Acquired with a Remidio smartphone fundus camera
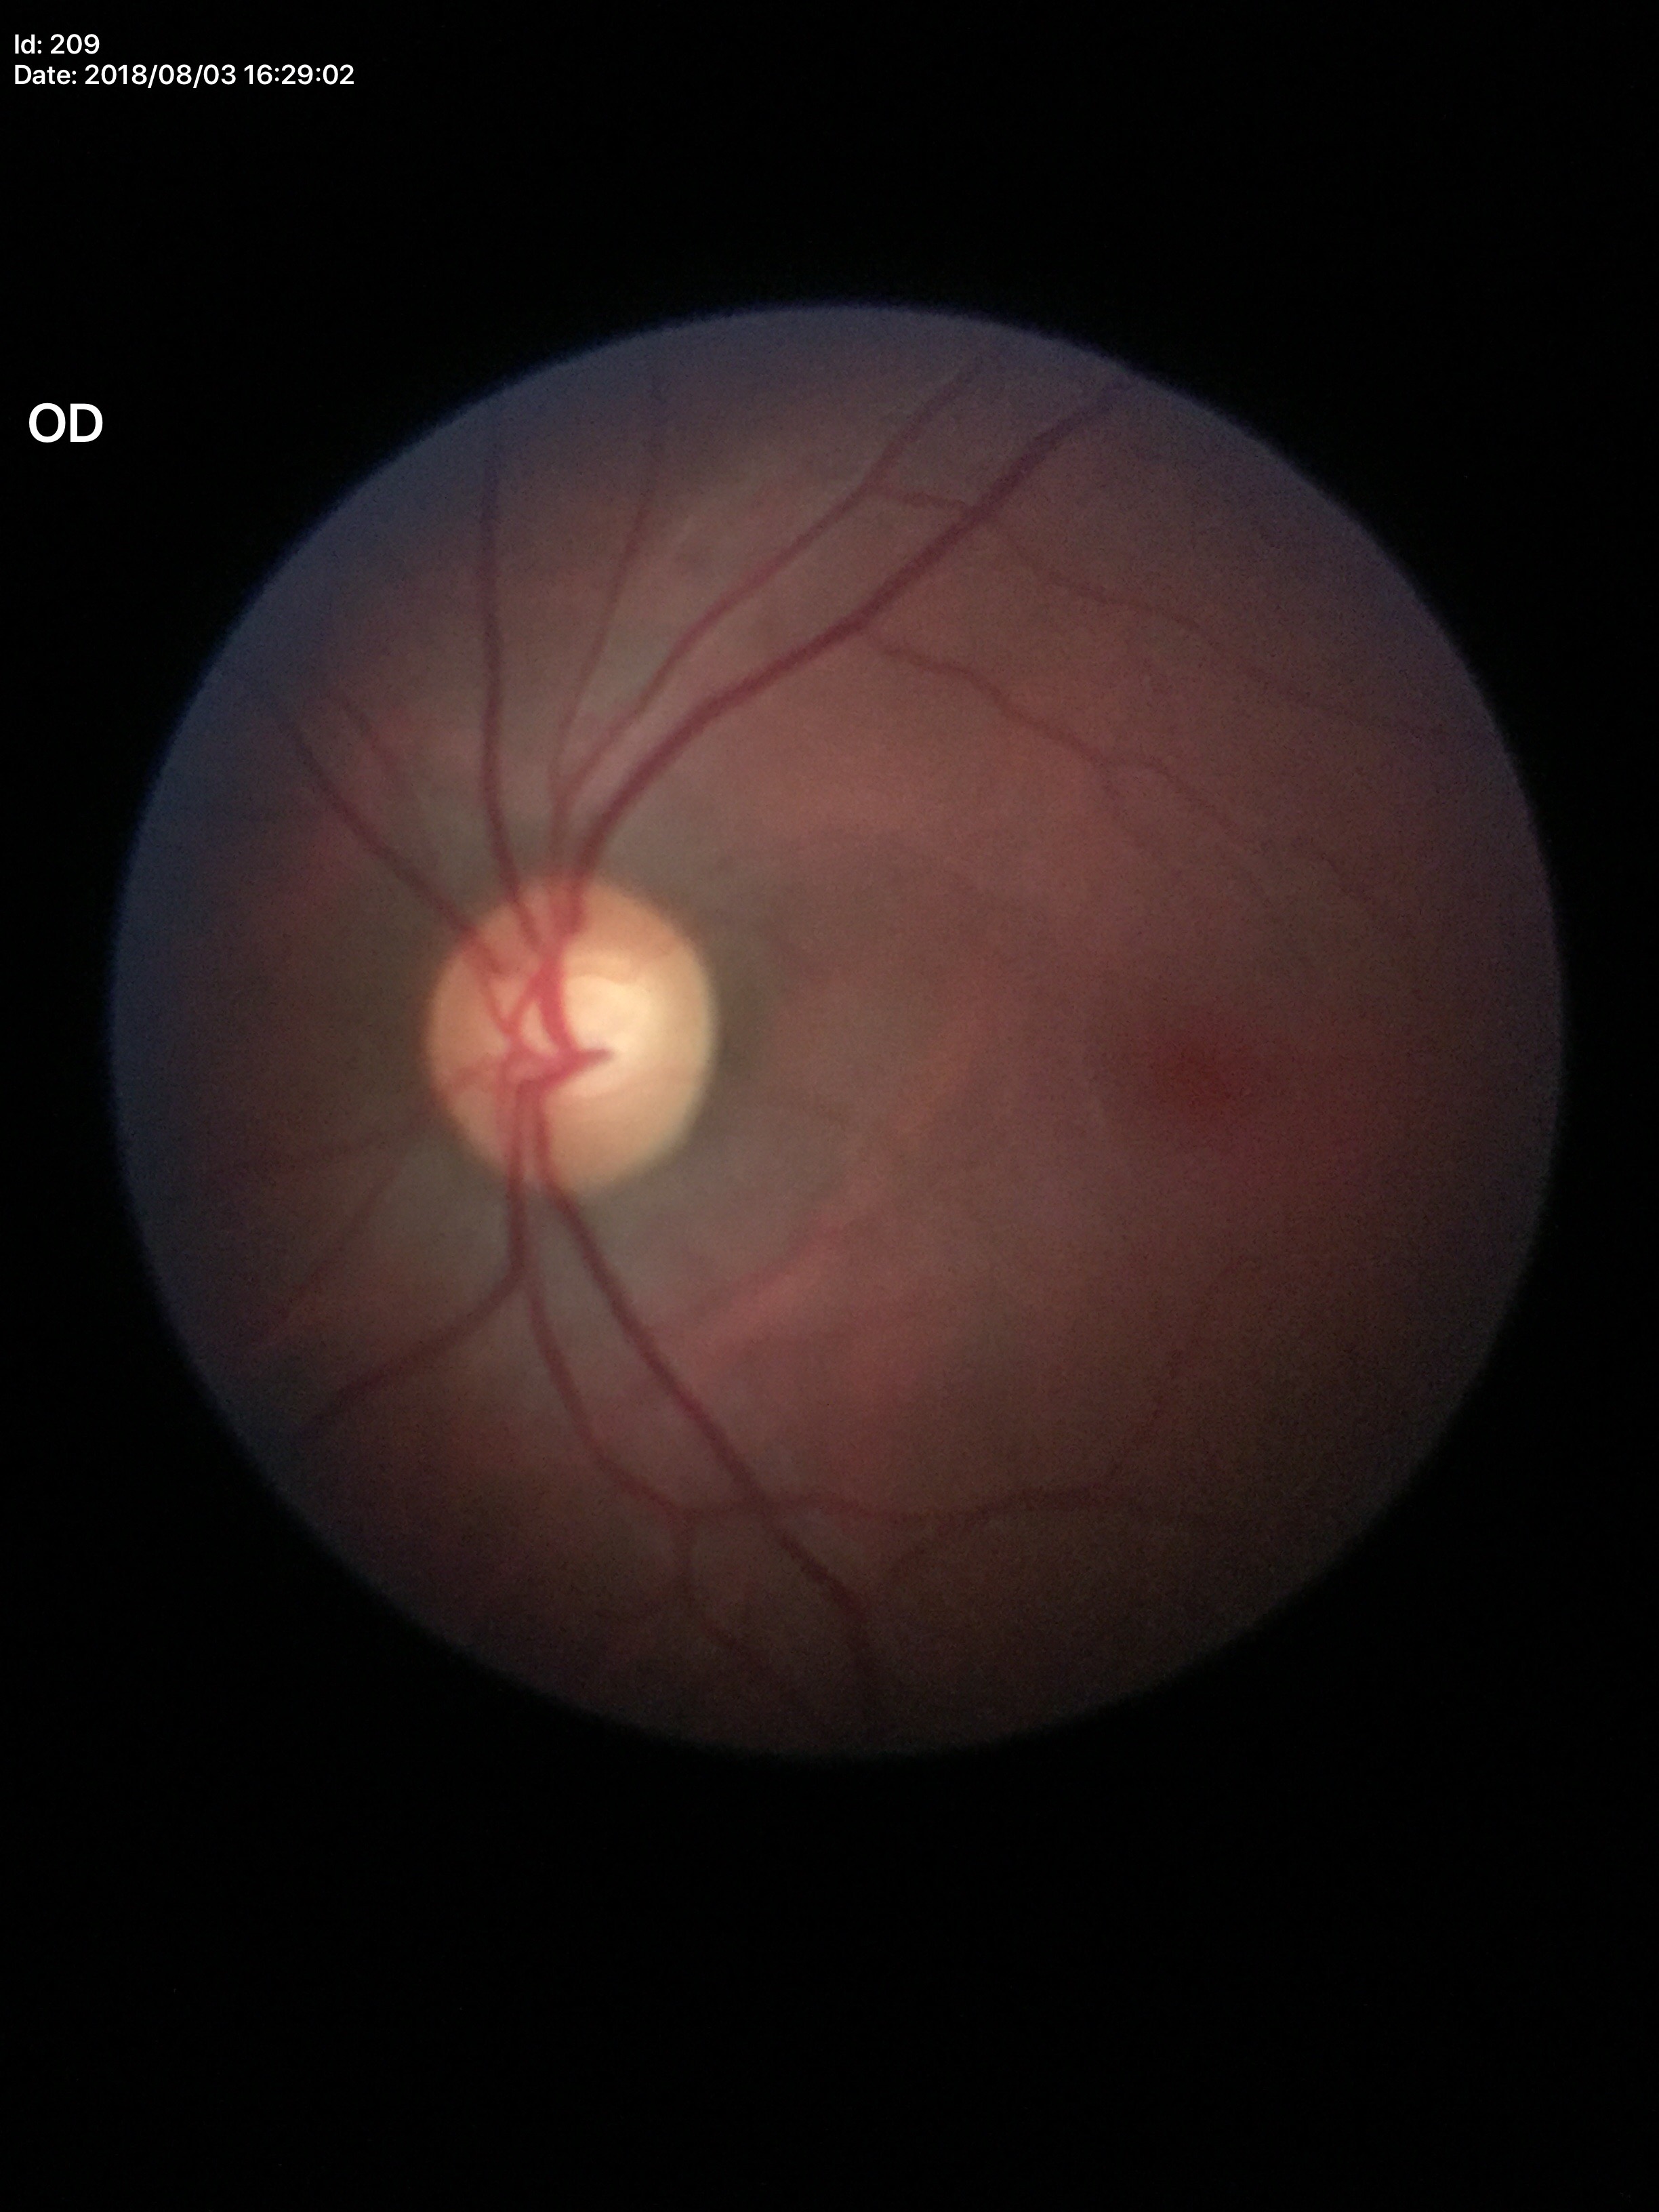 Q: What is the area cup-to-disc ratio?
A: 0.35
Q: Is there glaucoma suspicion?
A: not suspect
Q: What is the vertical cup-to-disc ratio?
A: 0.57